Ultra-widefield (UWF) fundus image — 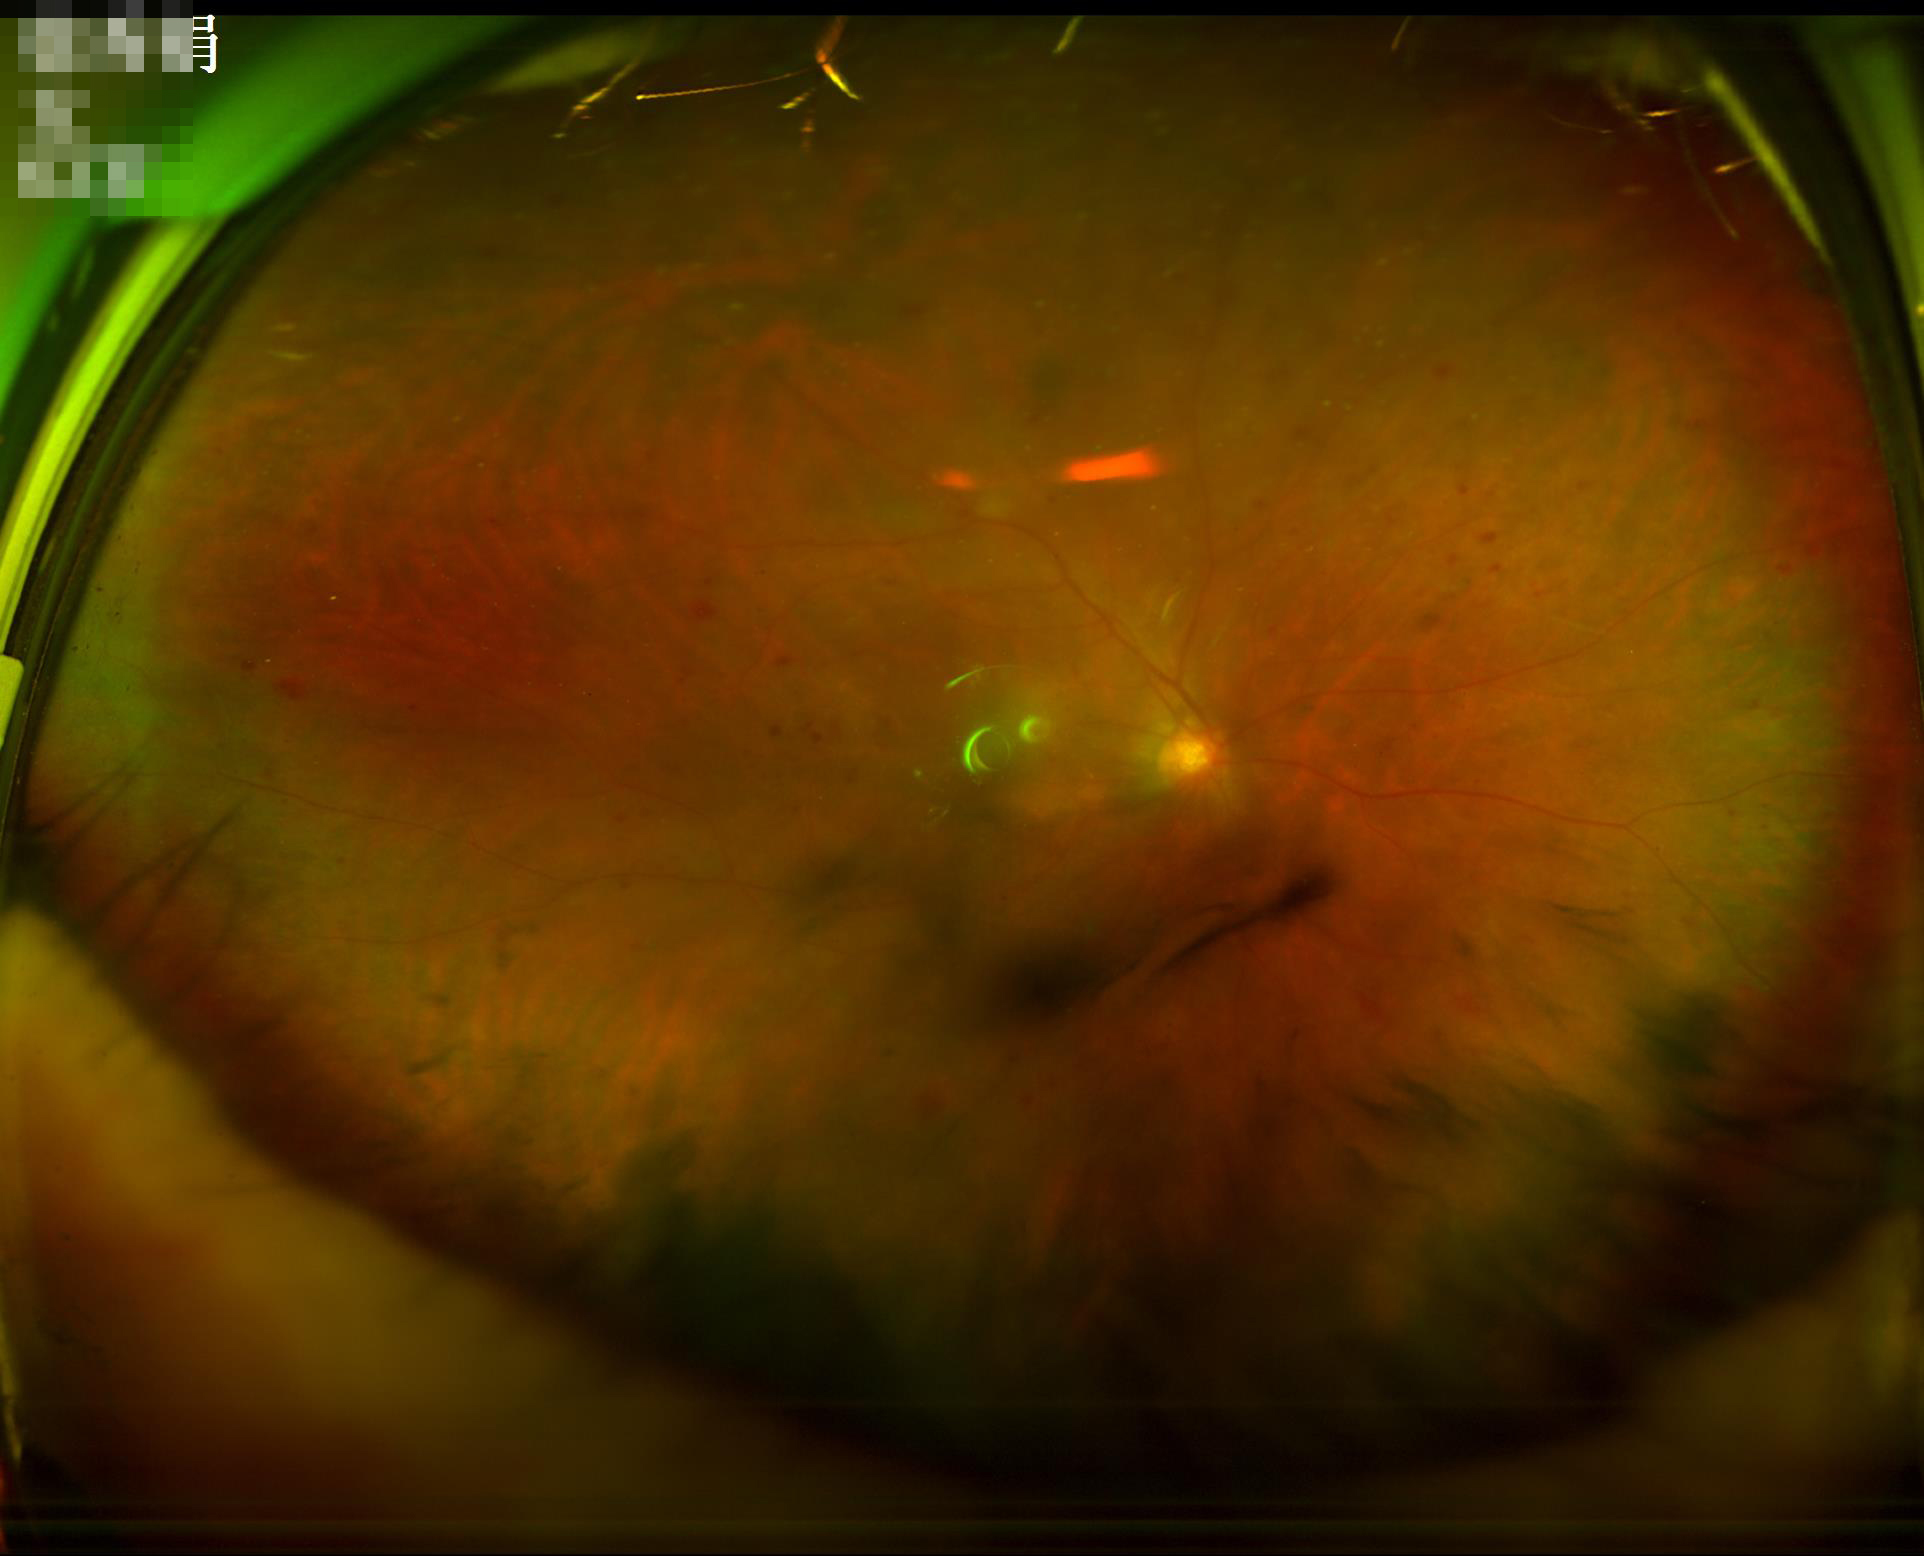
clarity: reduced sharpness with visible blur
illumination: over- or under-exposed
overall_quality: poor and difficult to use diagnostically